Retinal fundus photograph:
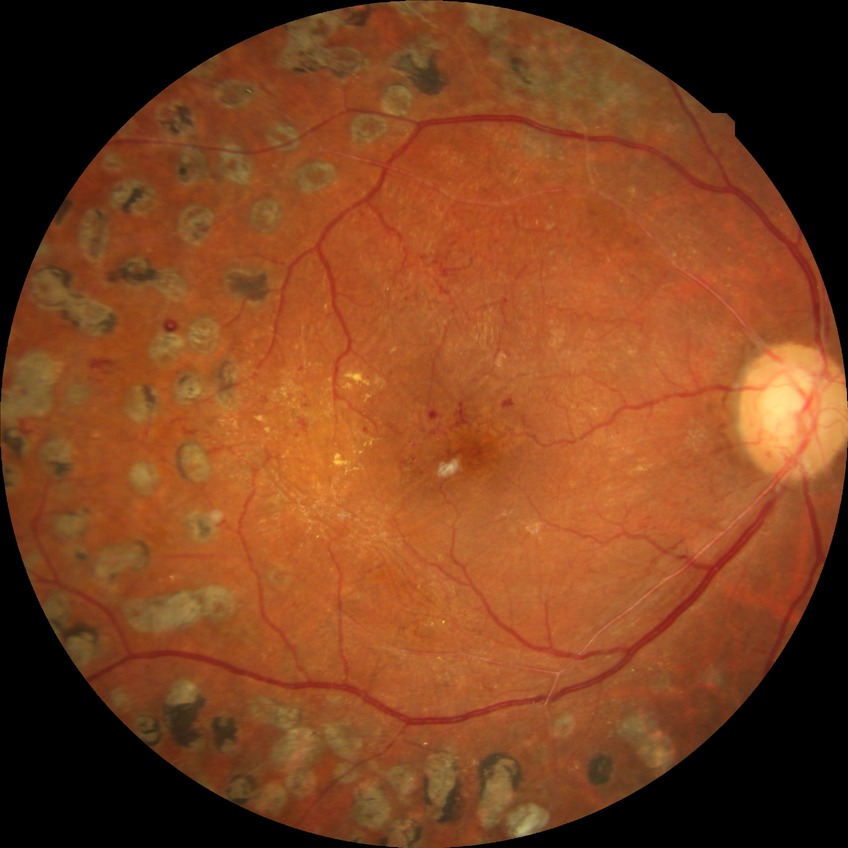 Diabetic retinopathy (DR) is PDR (proliferative diabetic retinopathy).